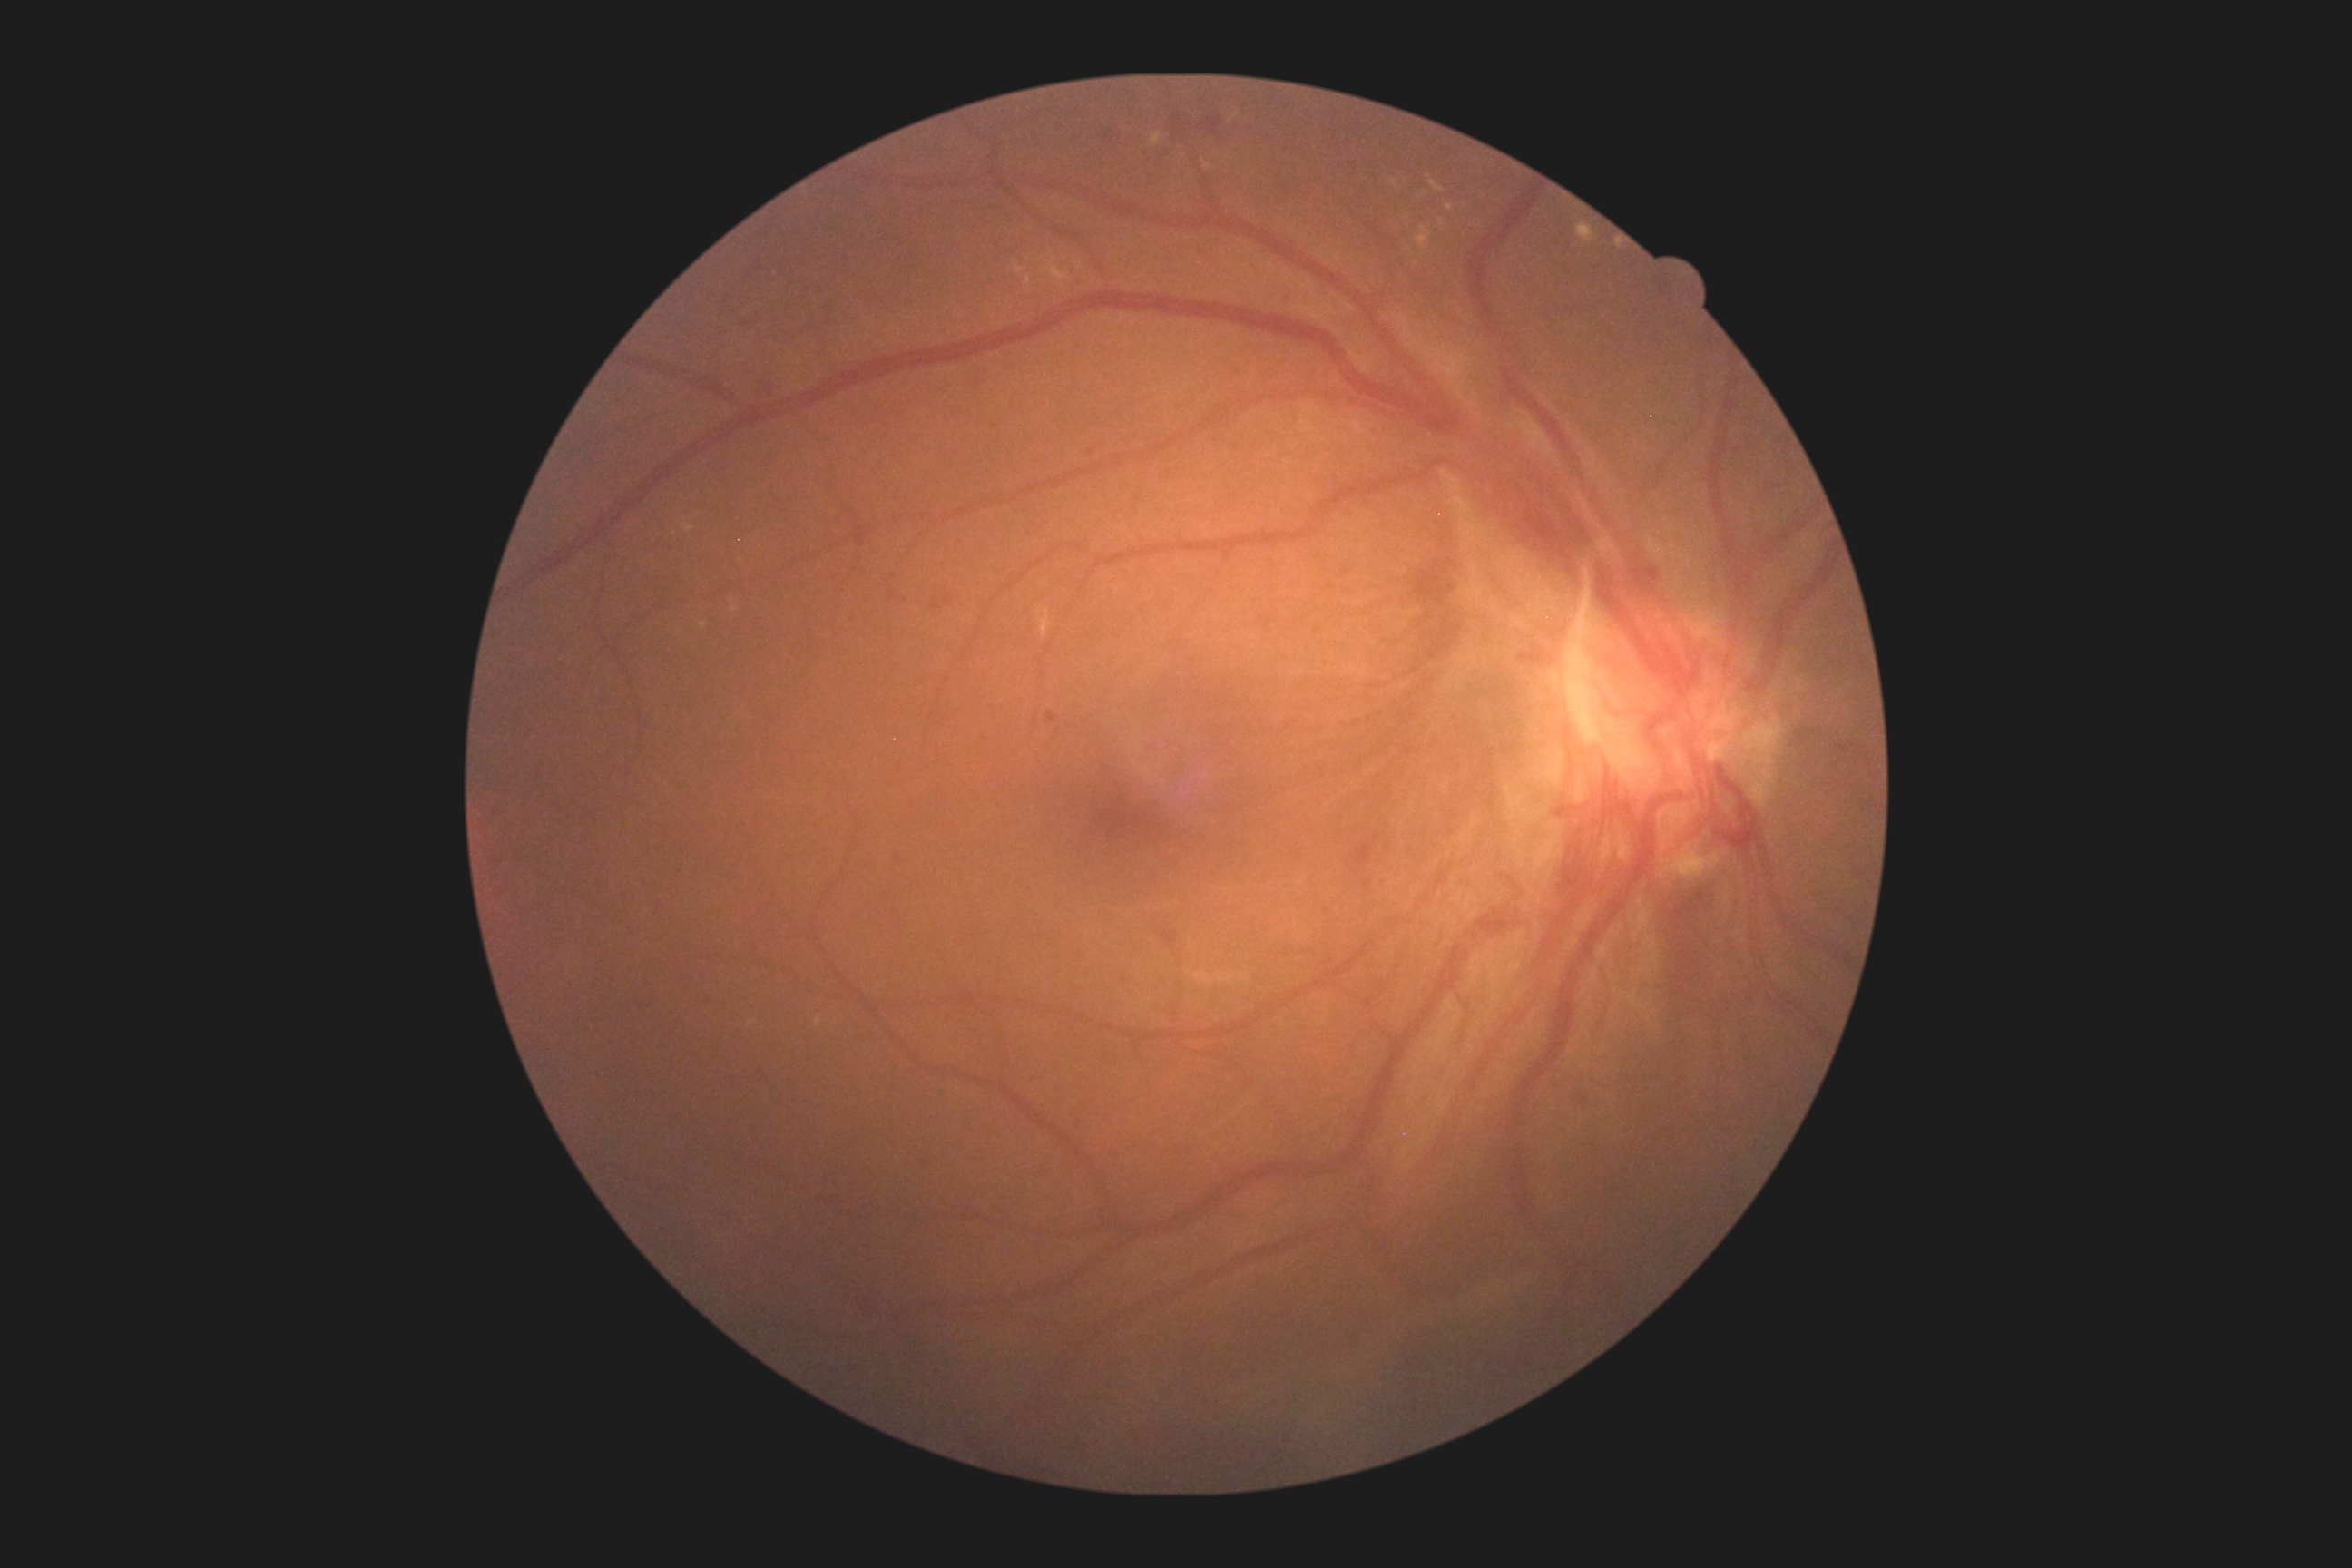
DR severity: grade 4 — neovascularization and/or vitreous/pre-retinal hemorrhage.